45-degree field of view · CFP · 1932 by 1910 pixels
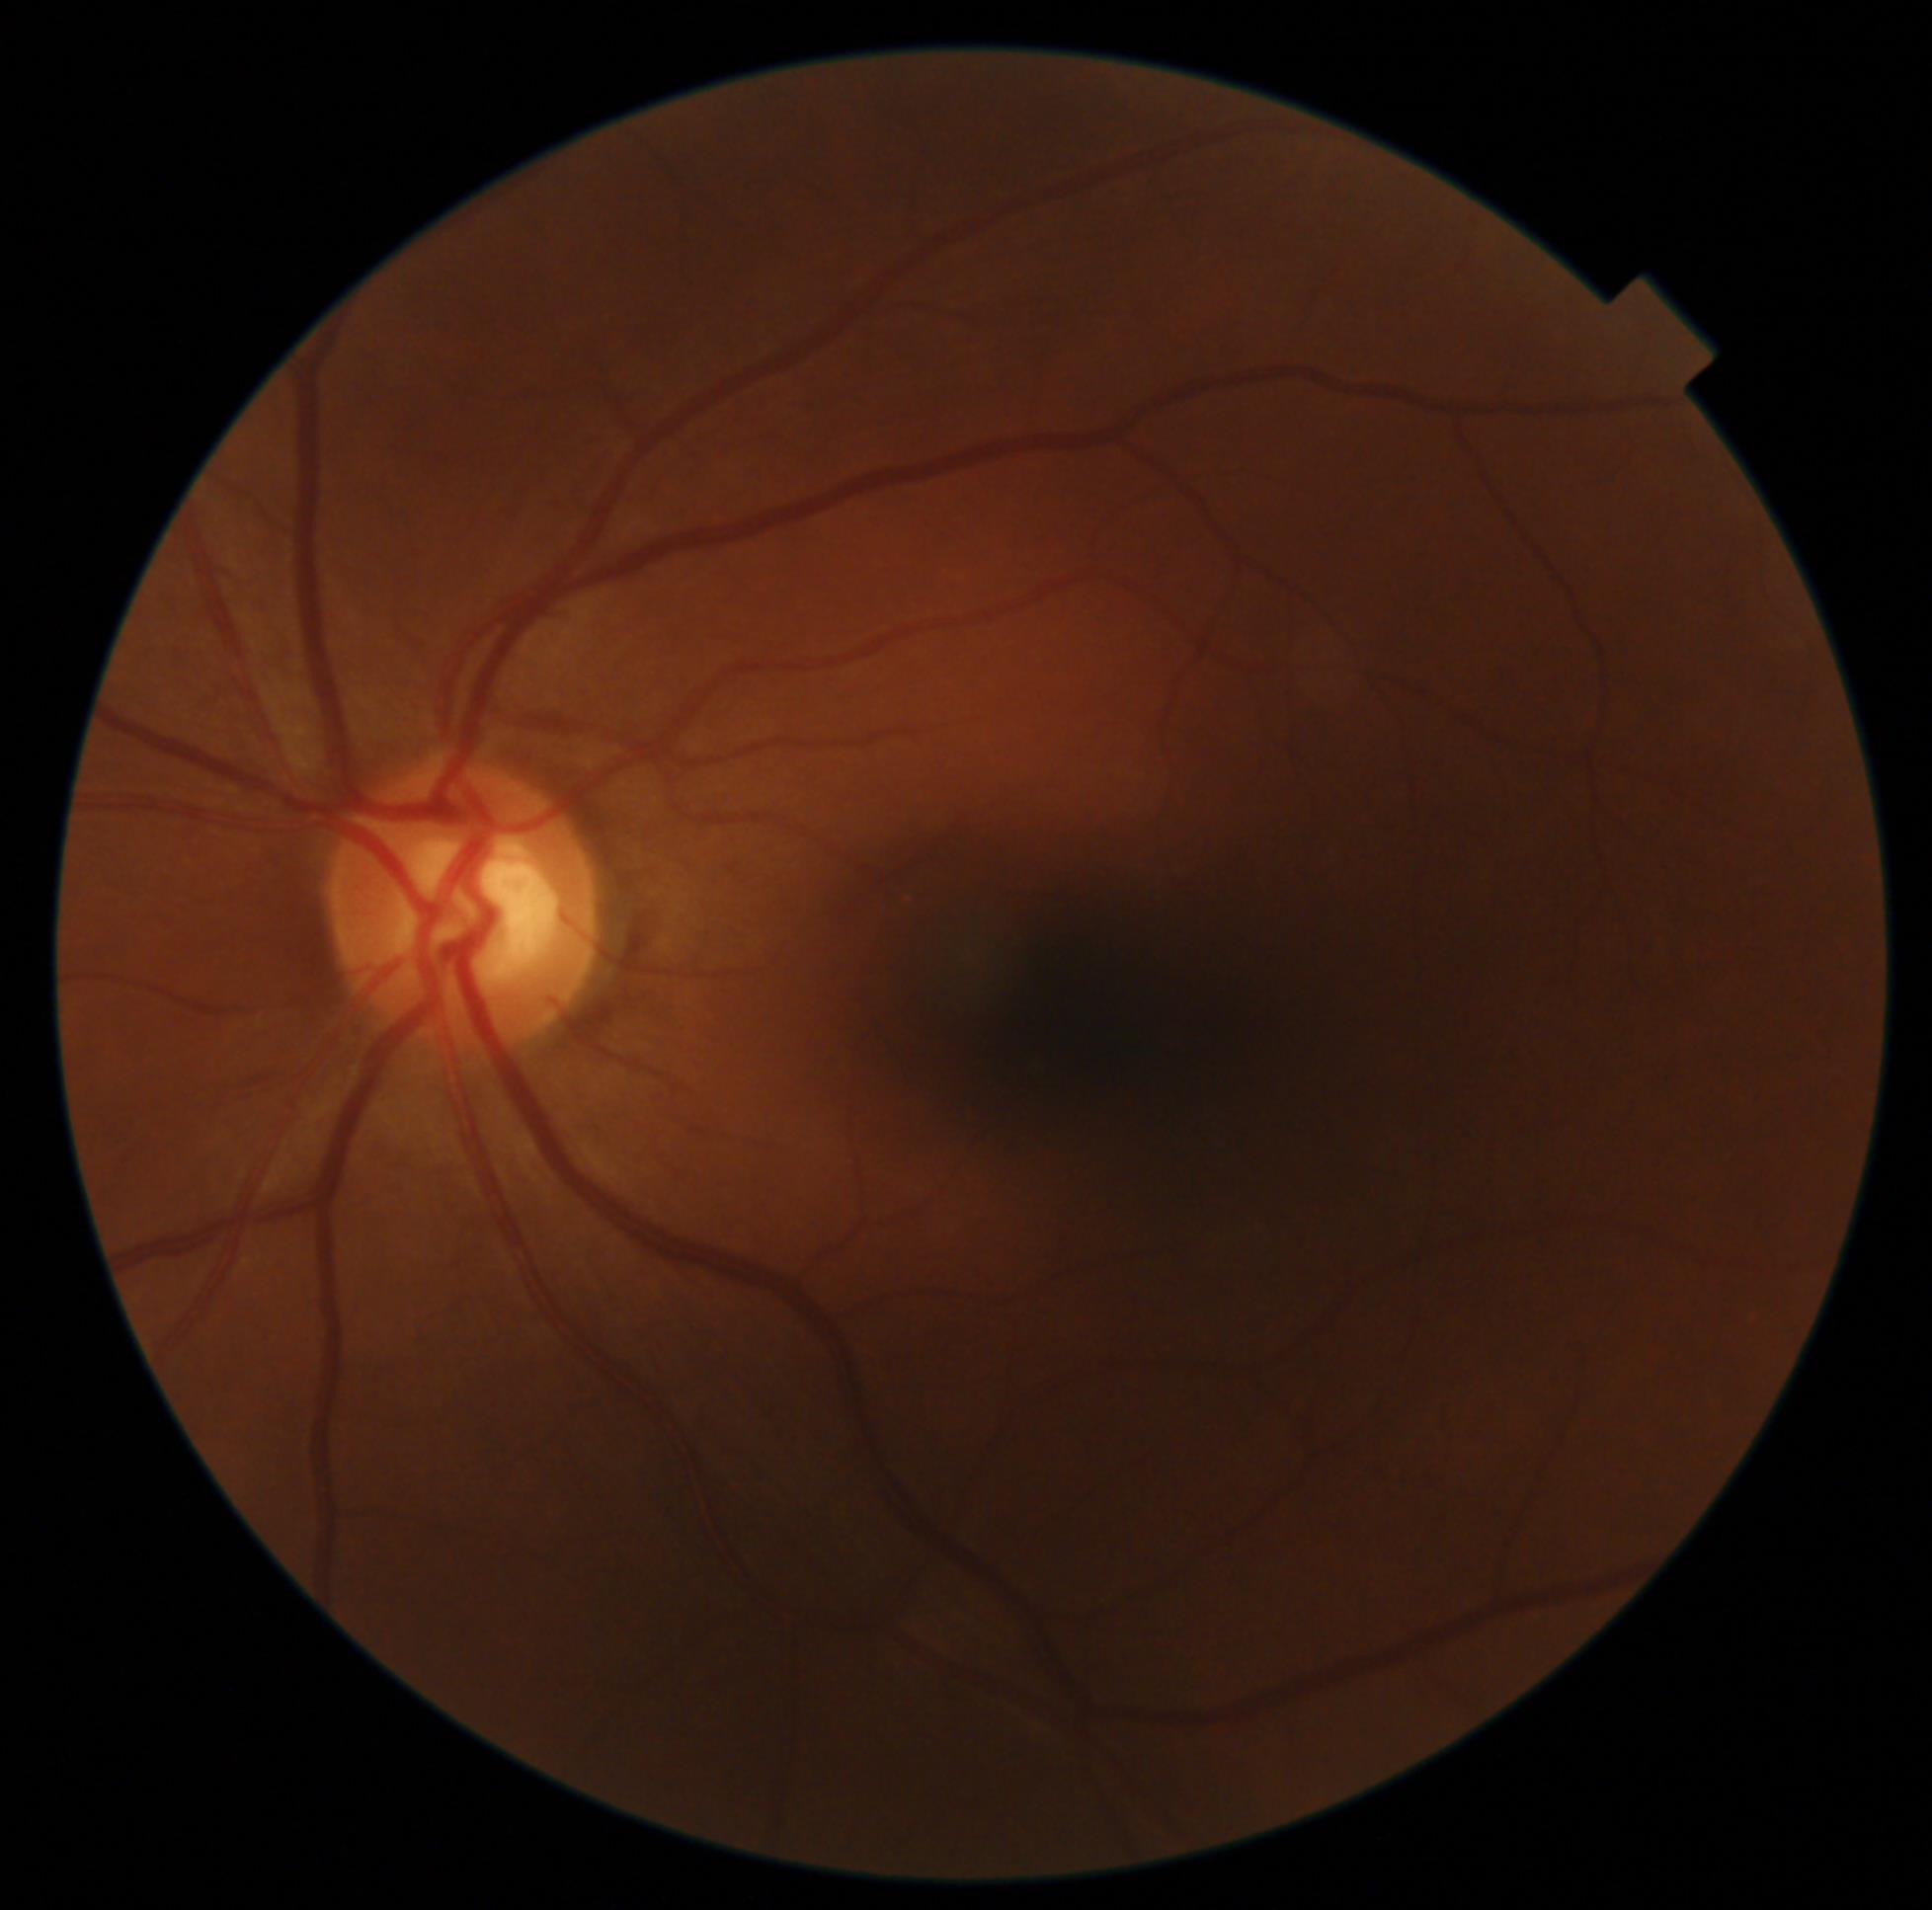
DR stage: 0/4.